45° FOV, color fundus photograph: 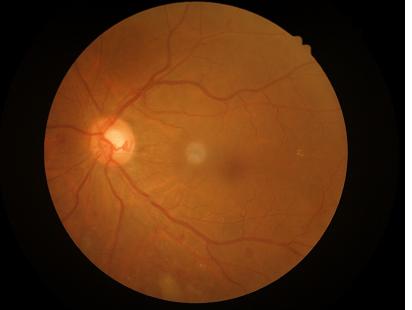

{
  "contrast": "good",
  "overall_quality": "satisfactory"
}